FOV: 45 degrees, modified Davis grading.
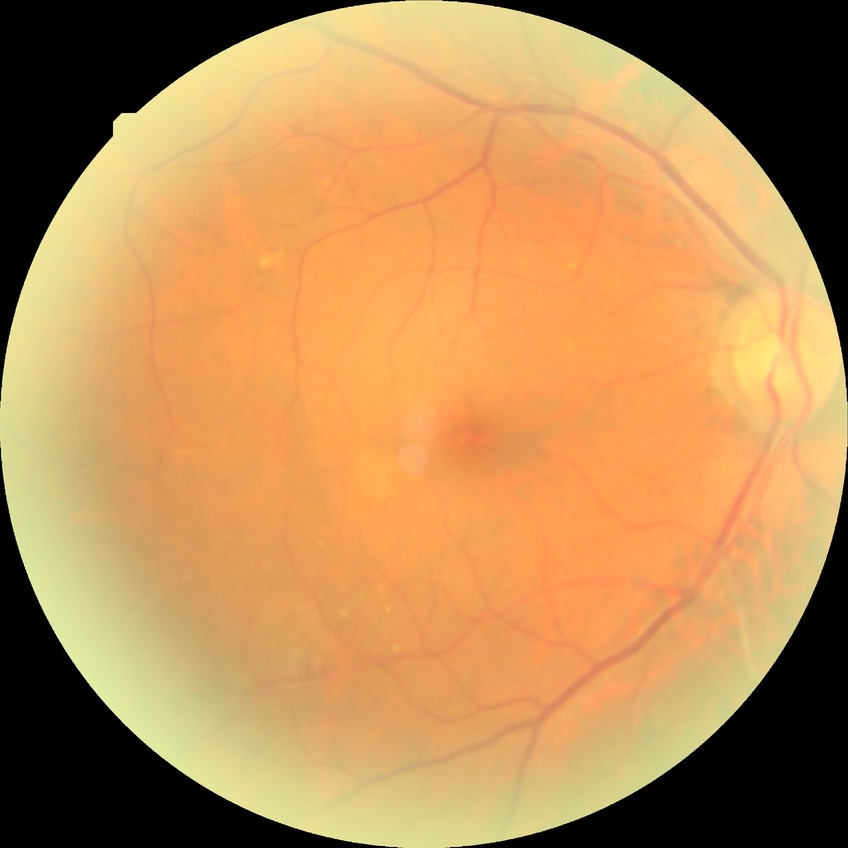

Davis grade: SDR.
Disease class: non-proliferative diabetic retinopathy.